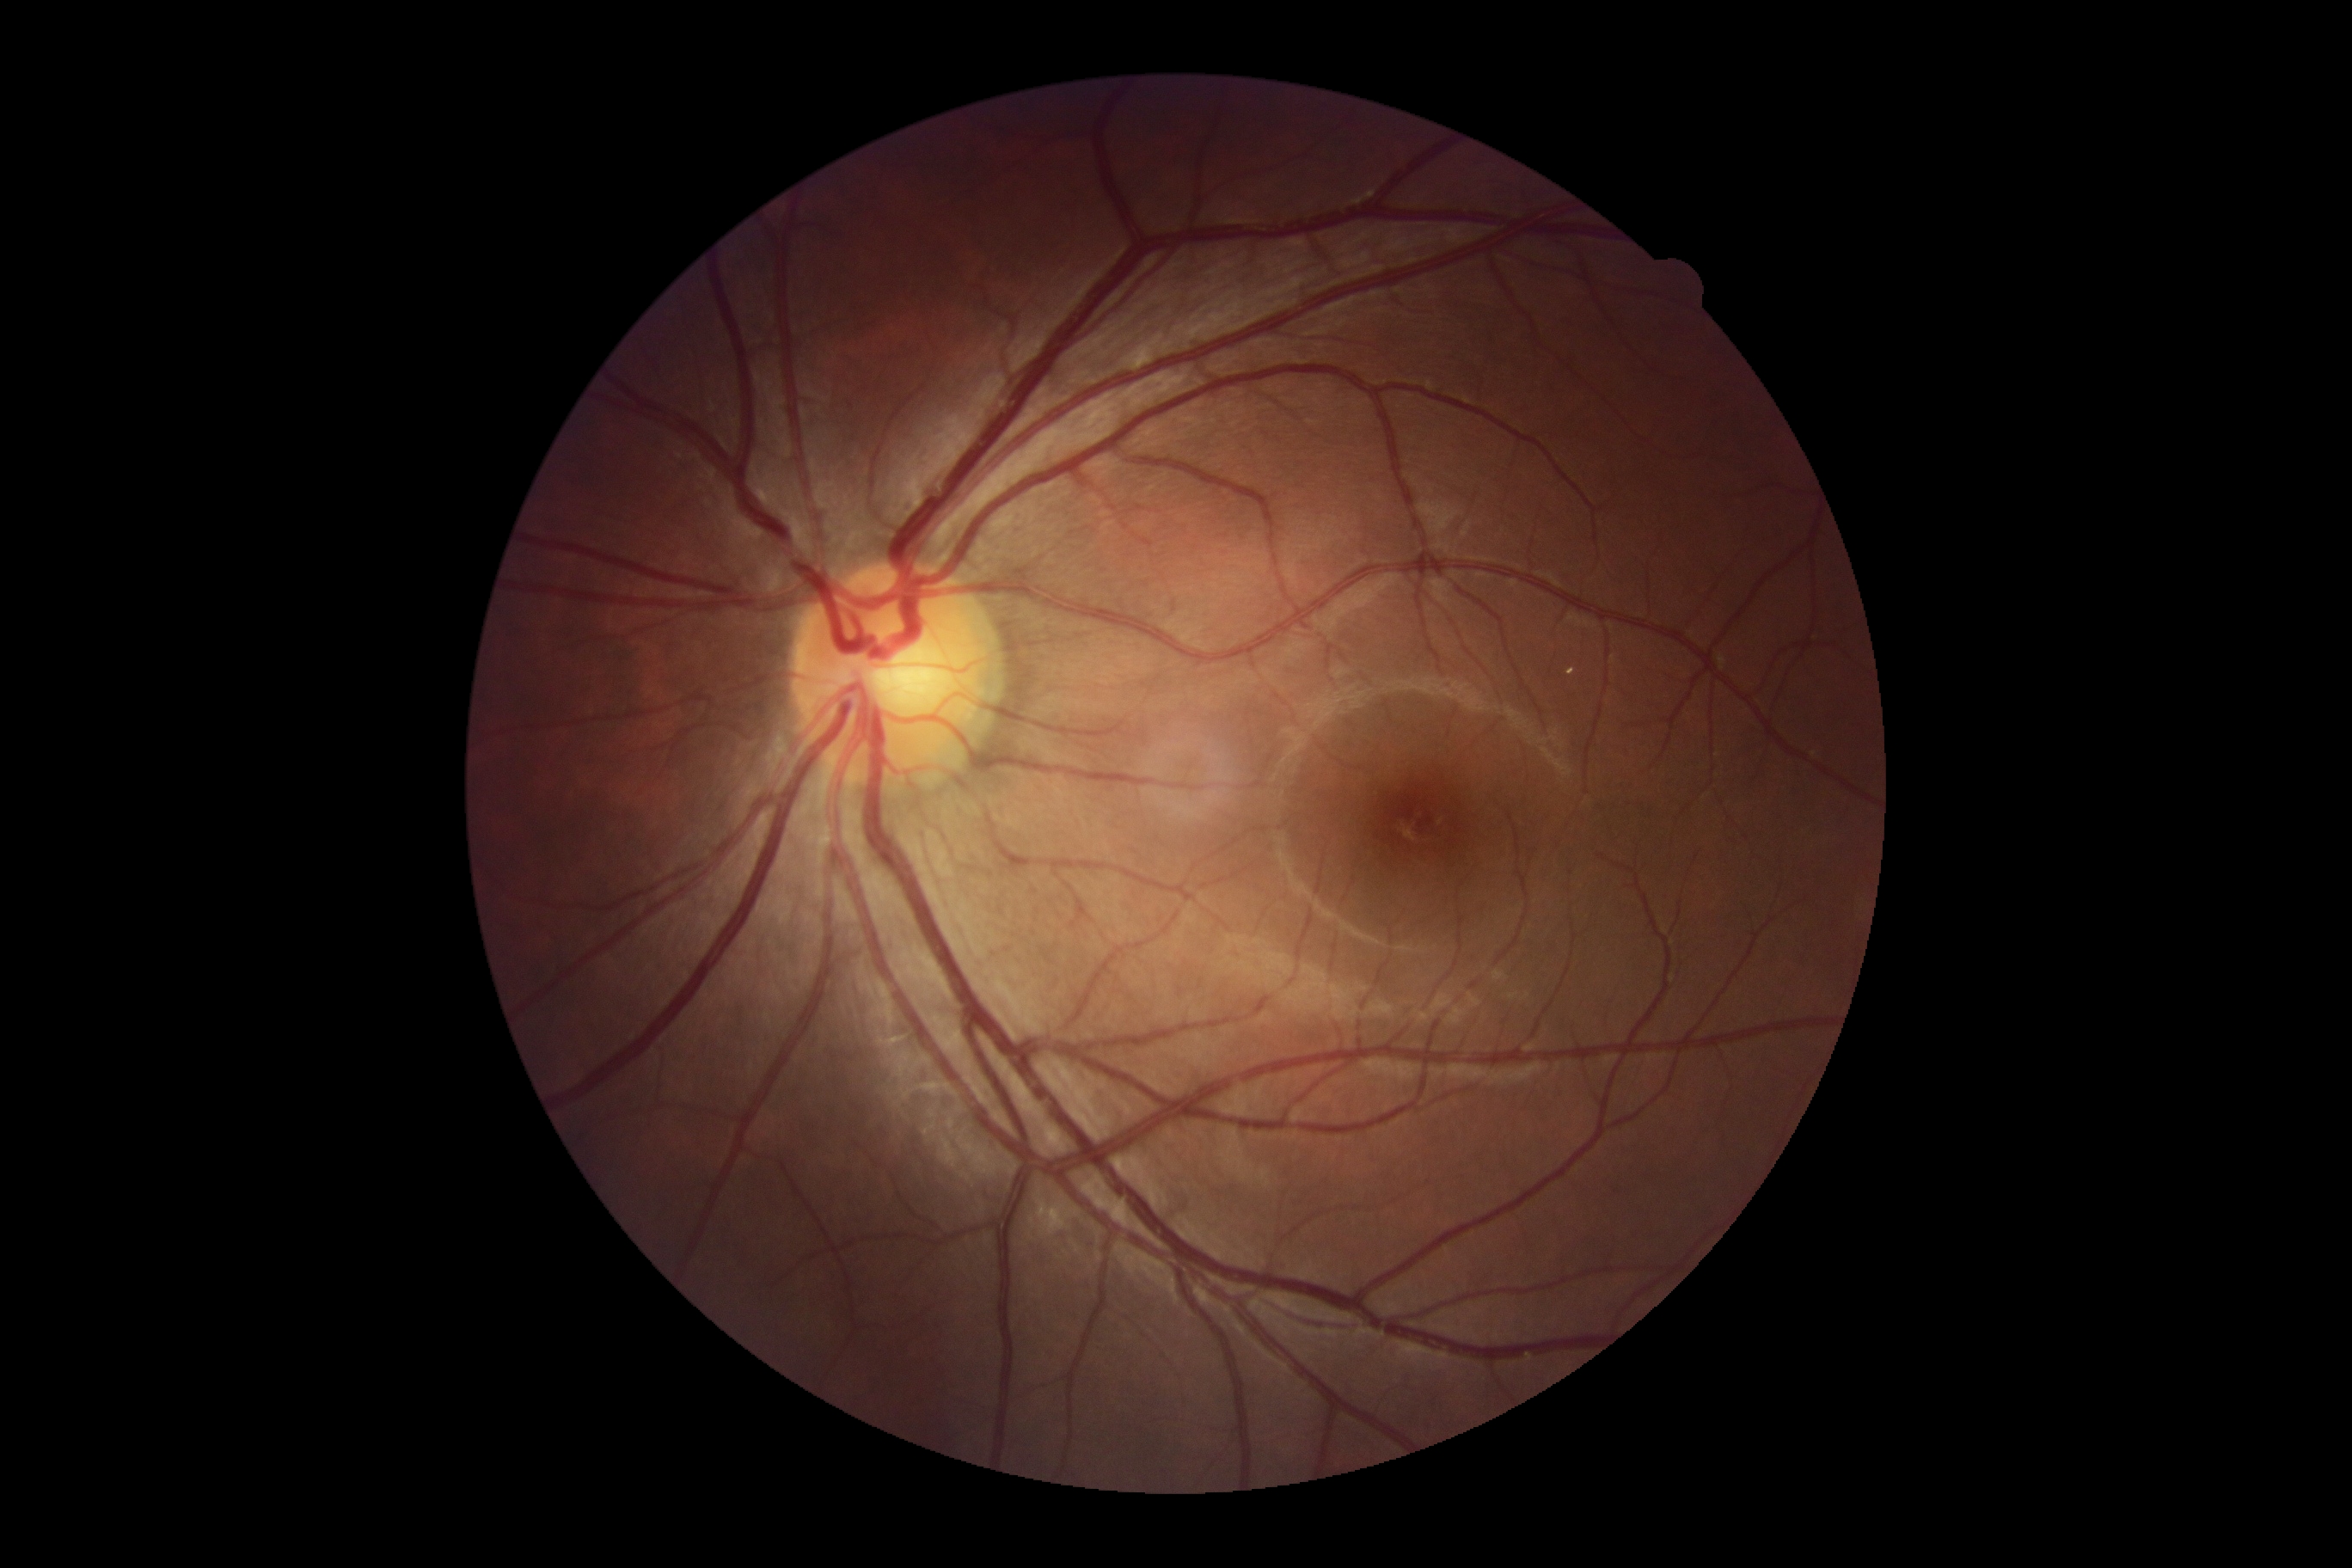 Diabetic retinopathy grade is 0 (no apparent retinopathy) — no visible signs of diabetic retinopathy.